Optic nerve head photograph:
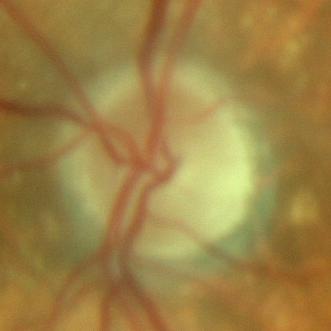 Consistent with no glaucomatous optic neuropathy.